1659 by 2212 pixels, retinal fundus photograph, acquired with a Remidio smartphone fundus camera: 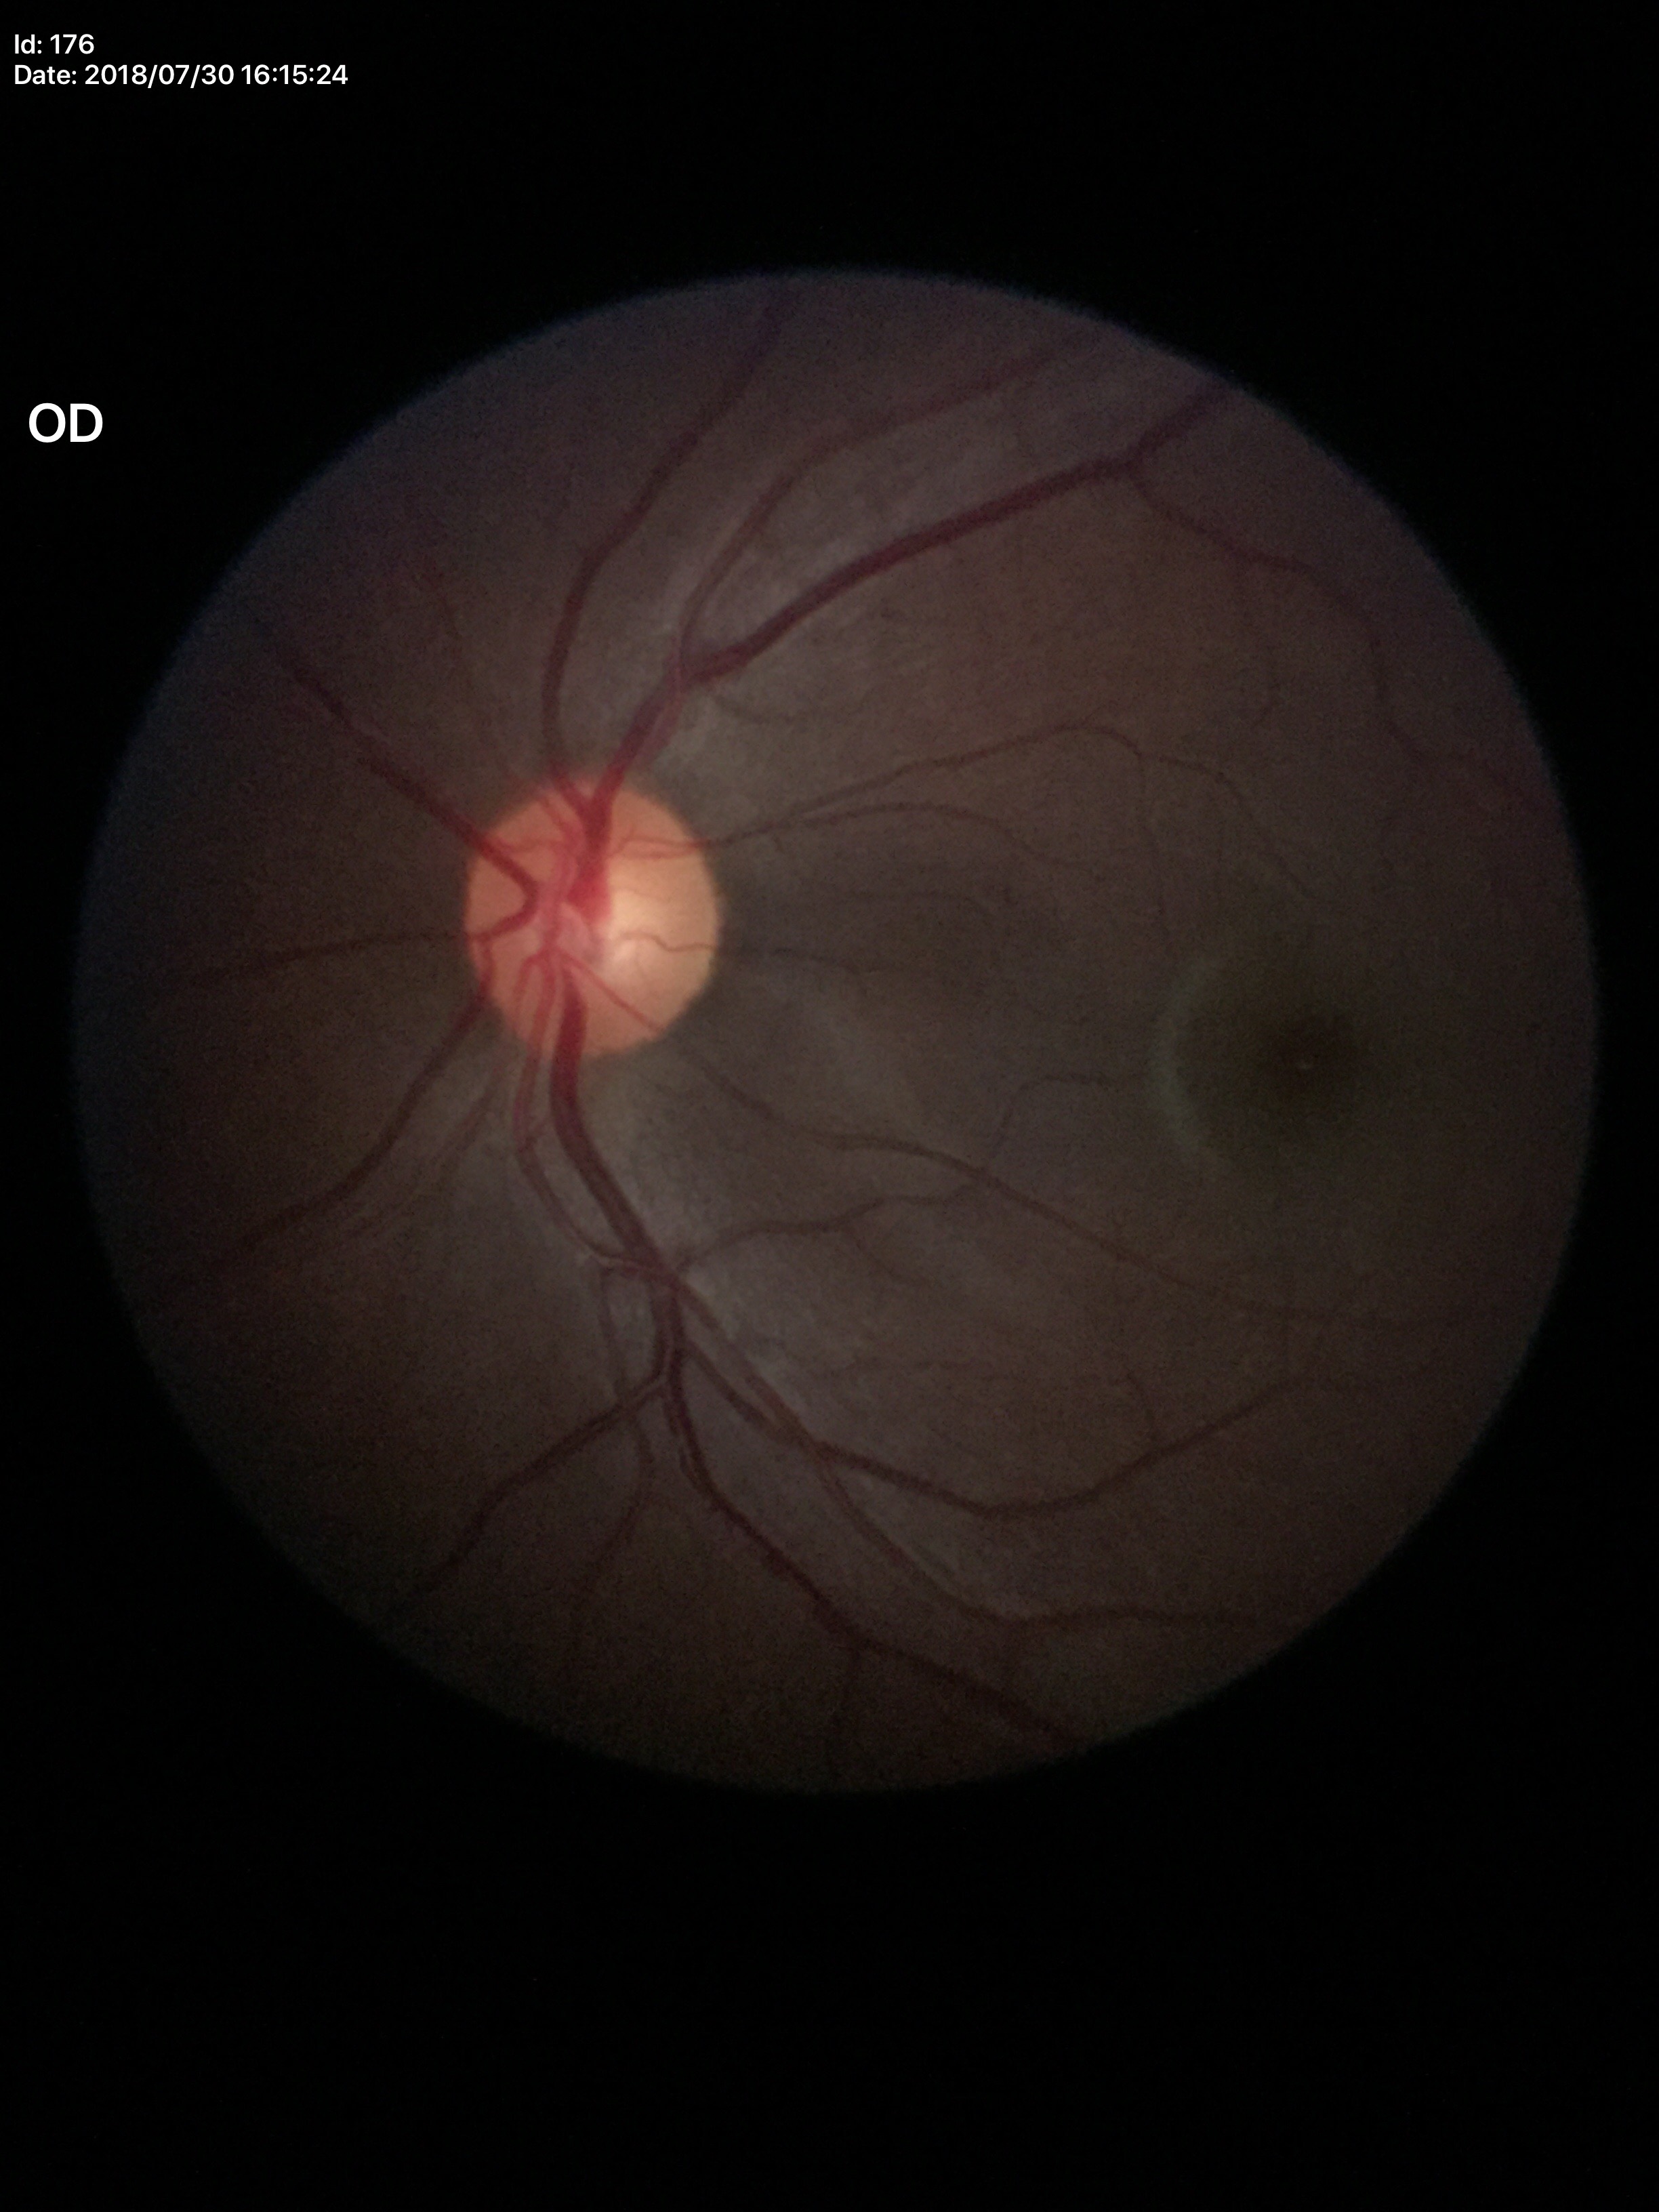
  glaucoma_decision: no suspicious findings
  vcdr: 0.51
  hcdr: 0.51